FOV: 45 degrees
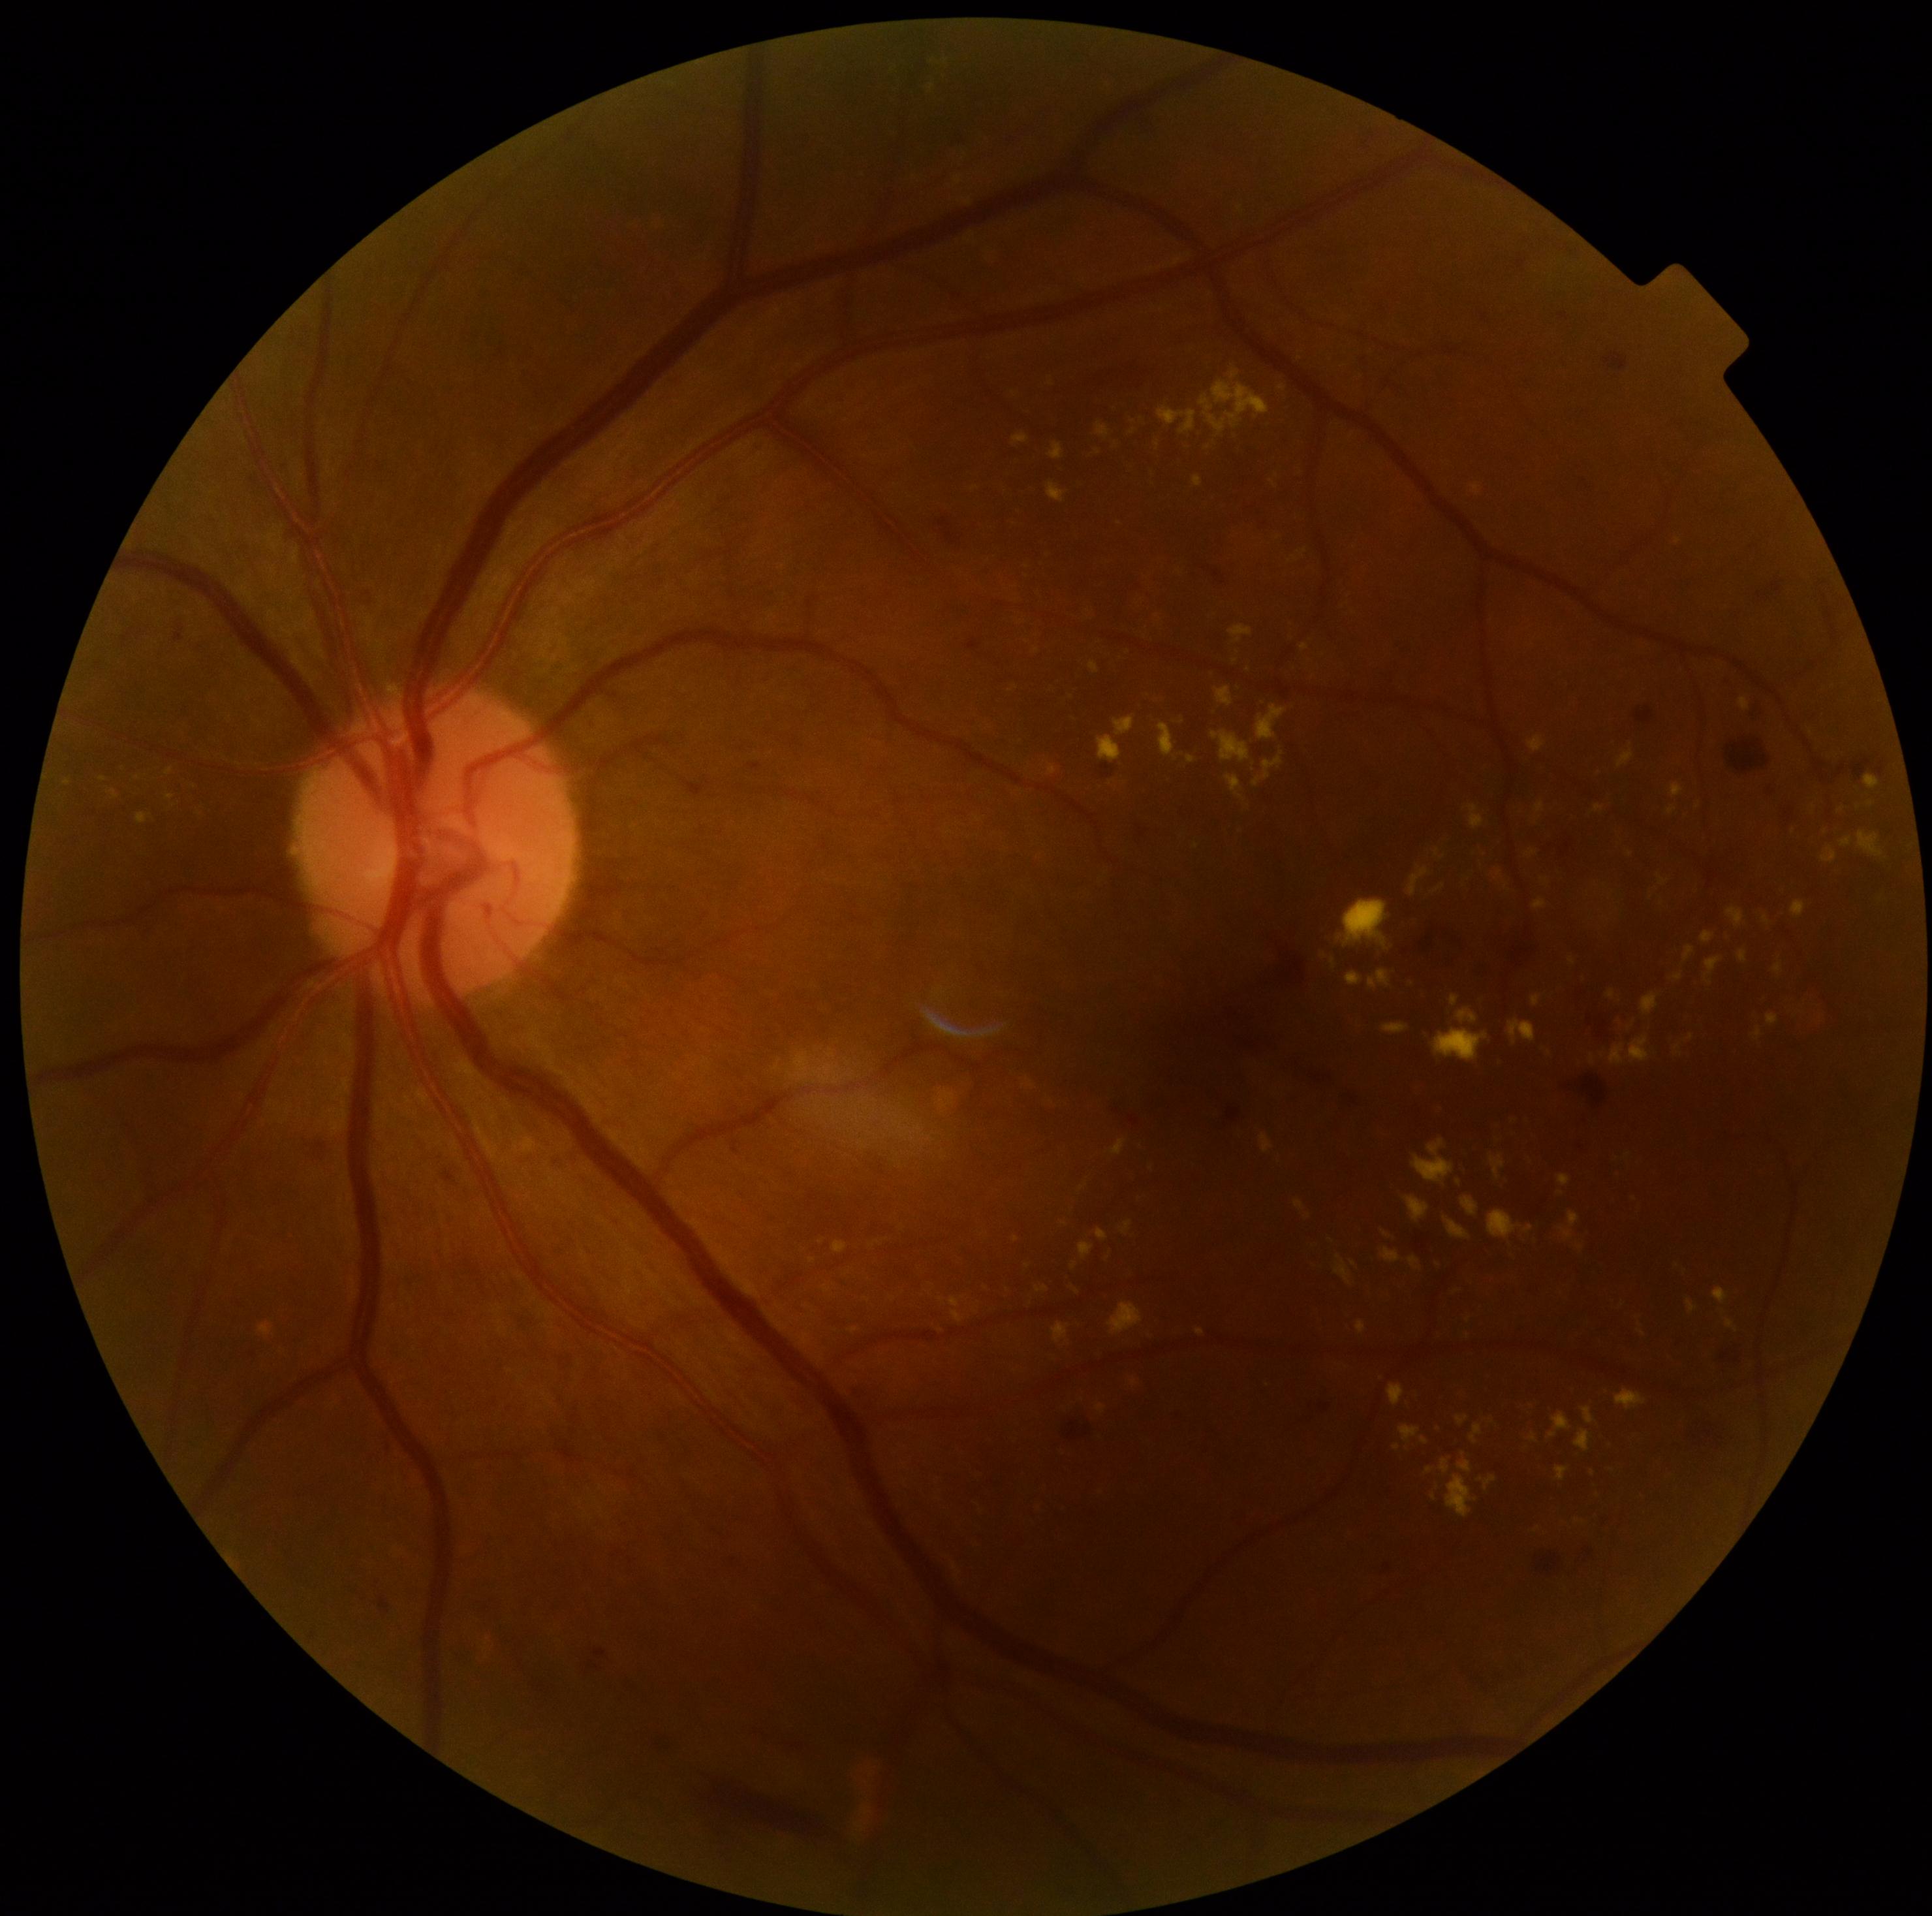 {"partial":true,"dr_grade":2,"dr_grade_name":"moderate NPDR","lesions":{"ex":[[1096,1229,1108,1242],[1098,736,1122,764],[1447,1474,1477,1517],[1229,625,1253,645],[1080,1243,1095,1260],[1557,1466,1570,1482],[822,1283,831,1294],[1668,807,1677,816],[1529,736,1546,753],[1687,1299,1696,1313],[1302,645,1311,652],[1456,1008,1478,1025]],"ex_small":[[1593,1059],[853,1330],[1249,669],[1017,1240],[1209,448],[103,779]]}}